FOV: 50 degrees; 2361 by 1568 pixels; centered on the macula; captured on a Kowa VX-10α fundus camera:
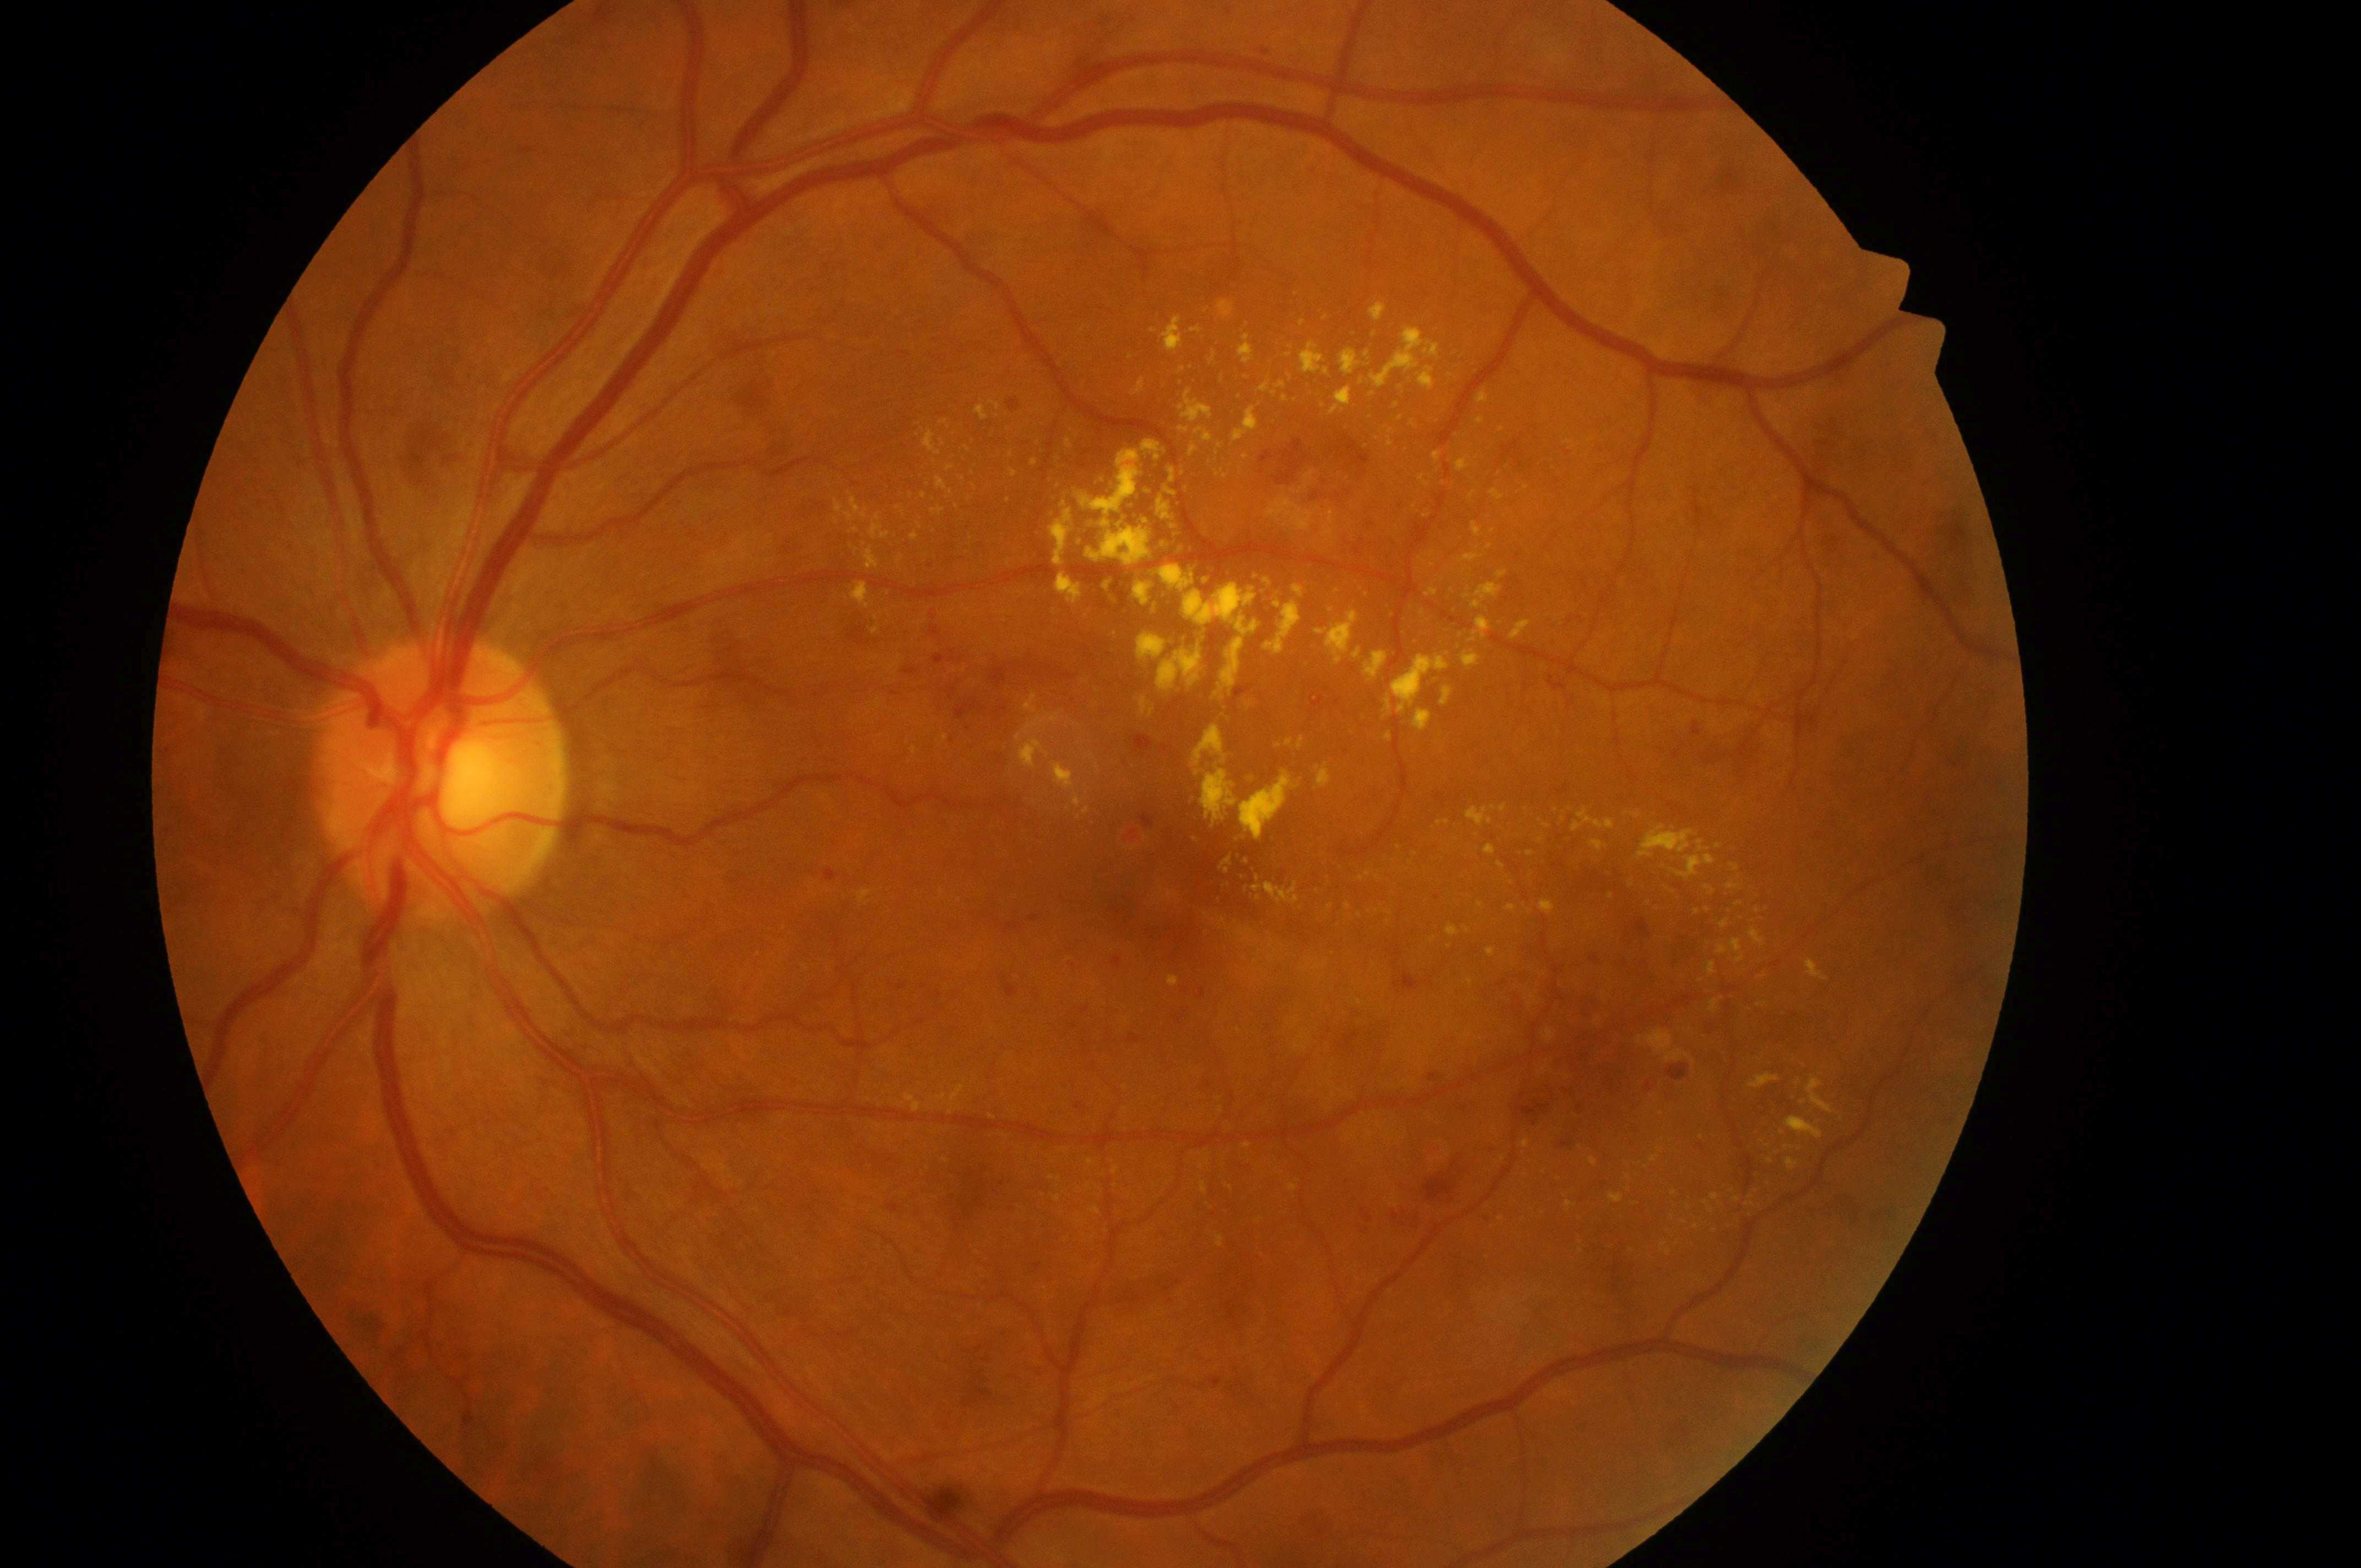
| field | value |
|---|---|
| the fovea | (x: 1165, y: 886) |
| eye | OS |
| DR grade | severe non-proliferative diabetic retinopathy (3) |
| DME grade | 2 (high risk) |
| optic disc center | (x: 439, y: 787) |